Color fundus image:
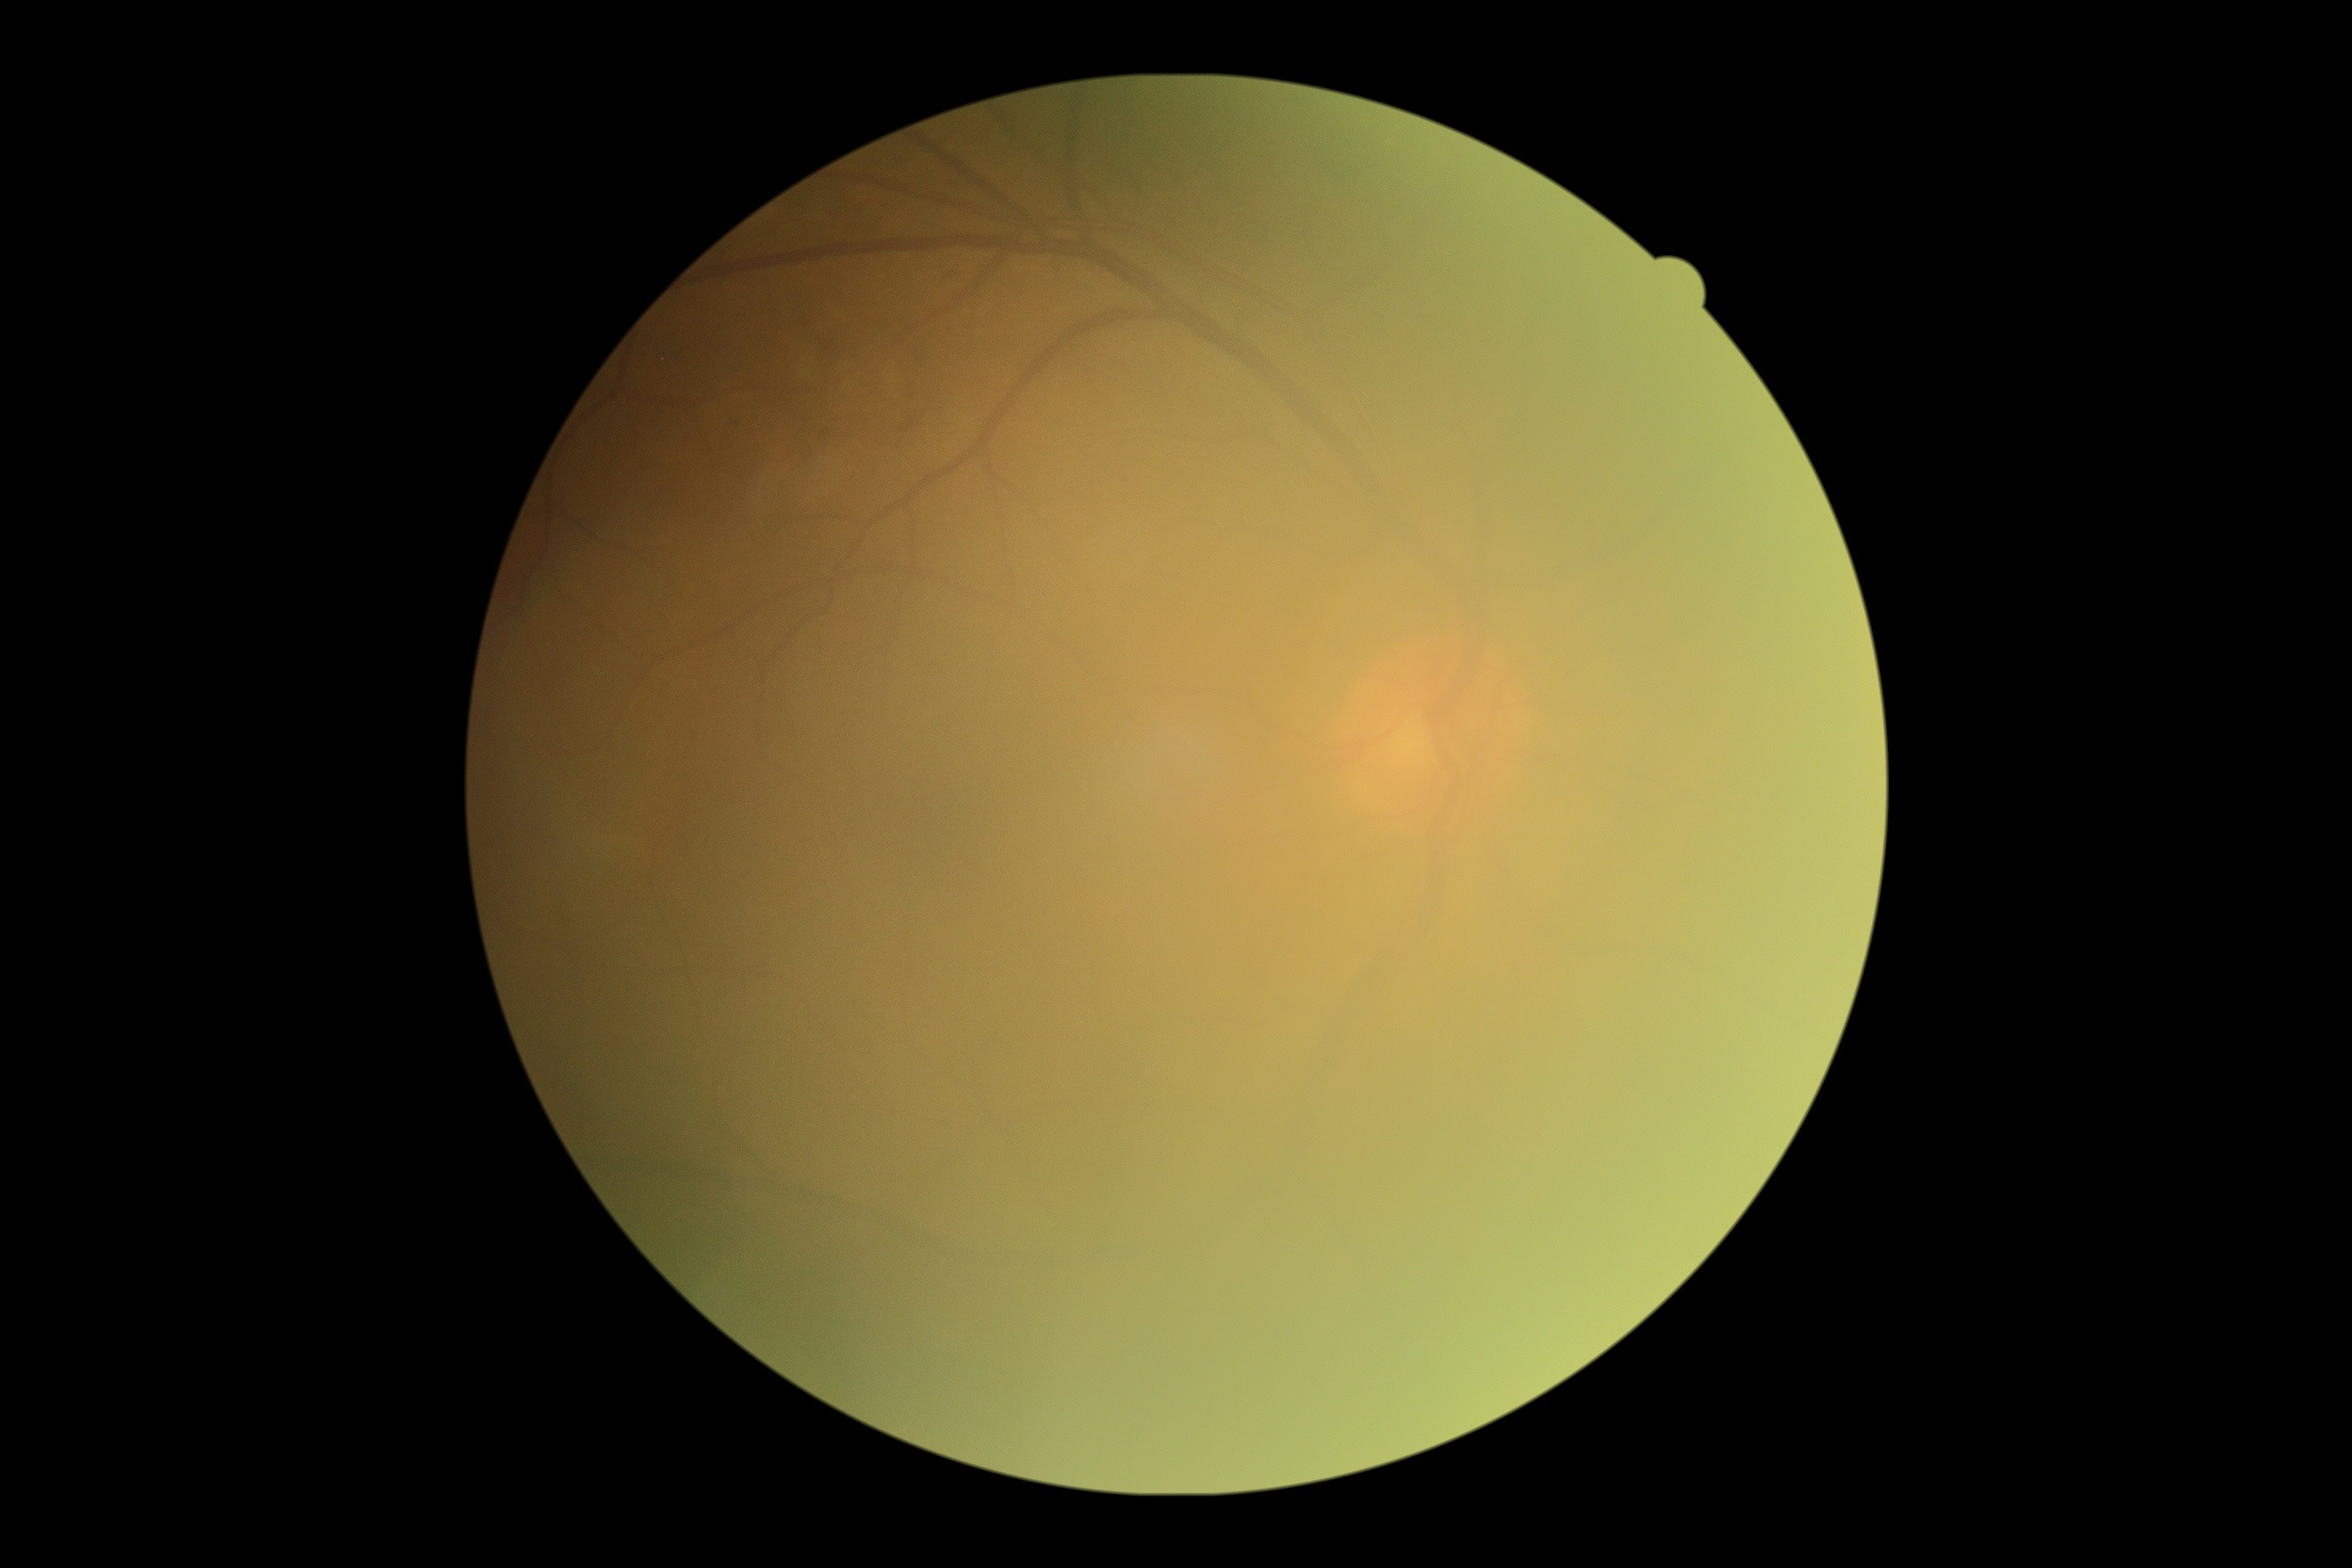

Diabetic retinopathy (DR): grade 0 (no apparent retinopathy).